45° field of view. Modified Davis classification — 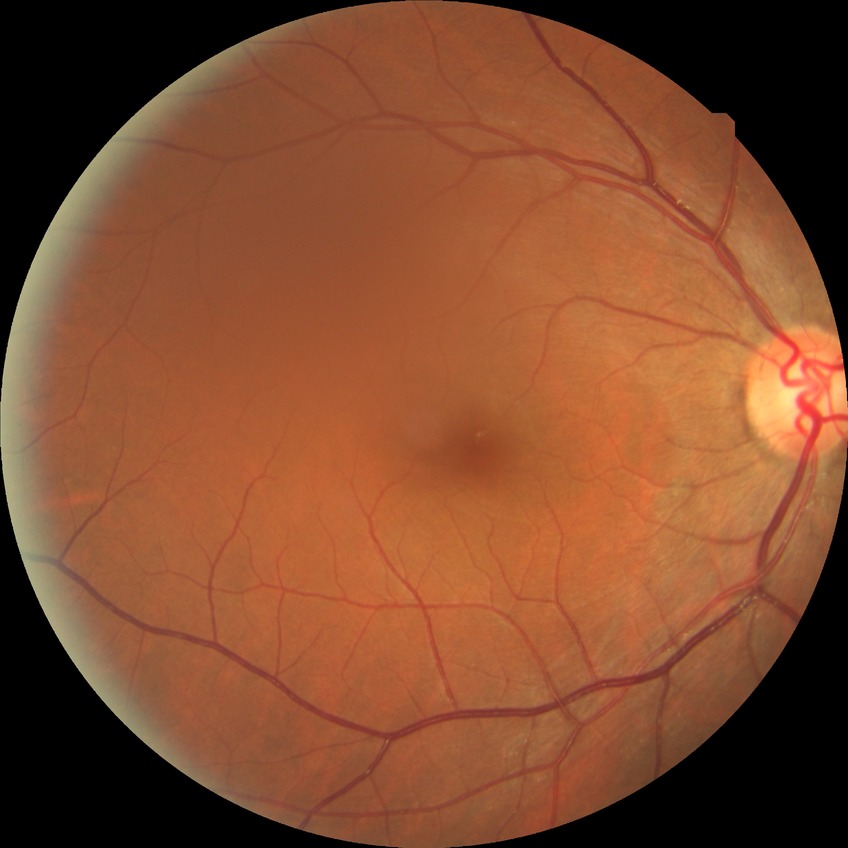

Diabetic retinopathy (DR): no diabetic retinopathy (NDR).